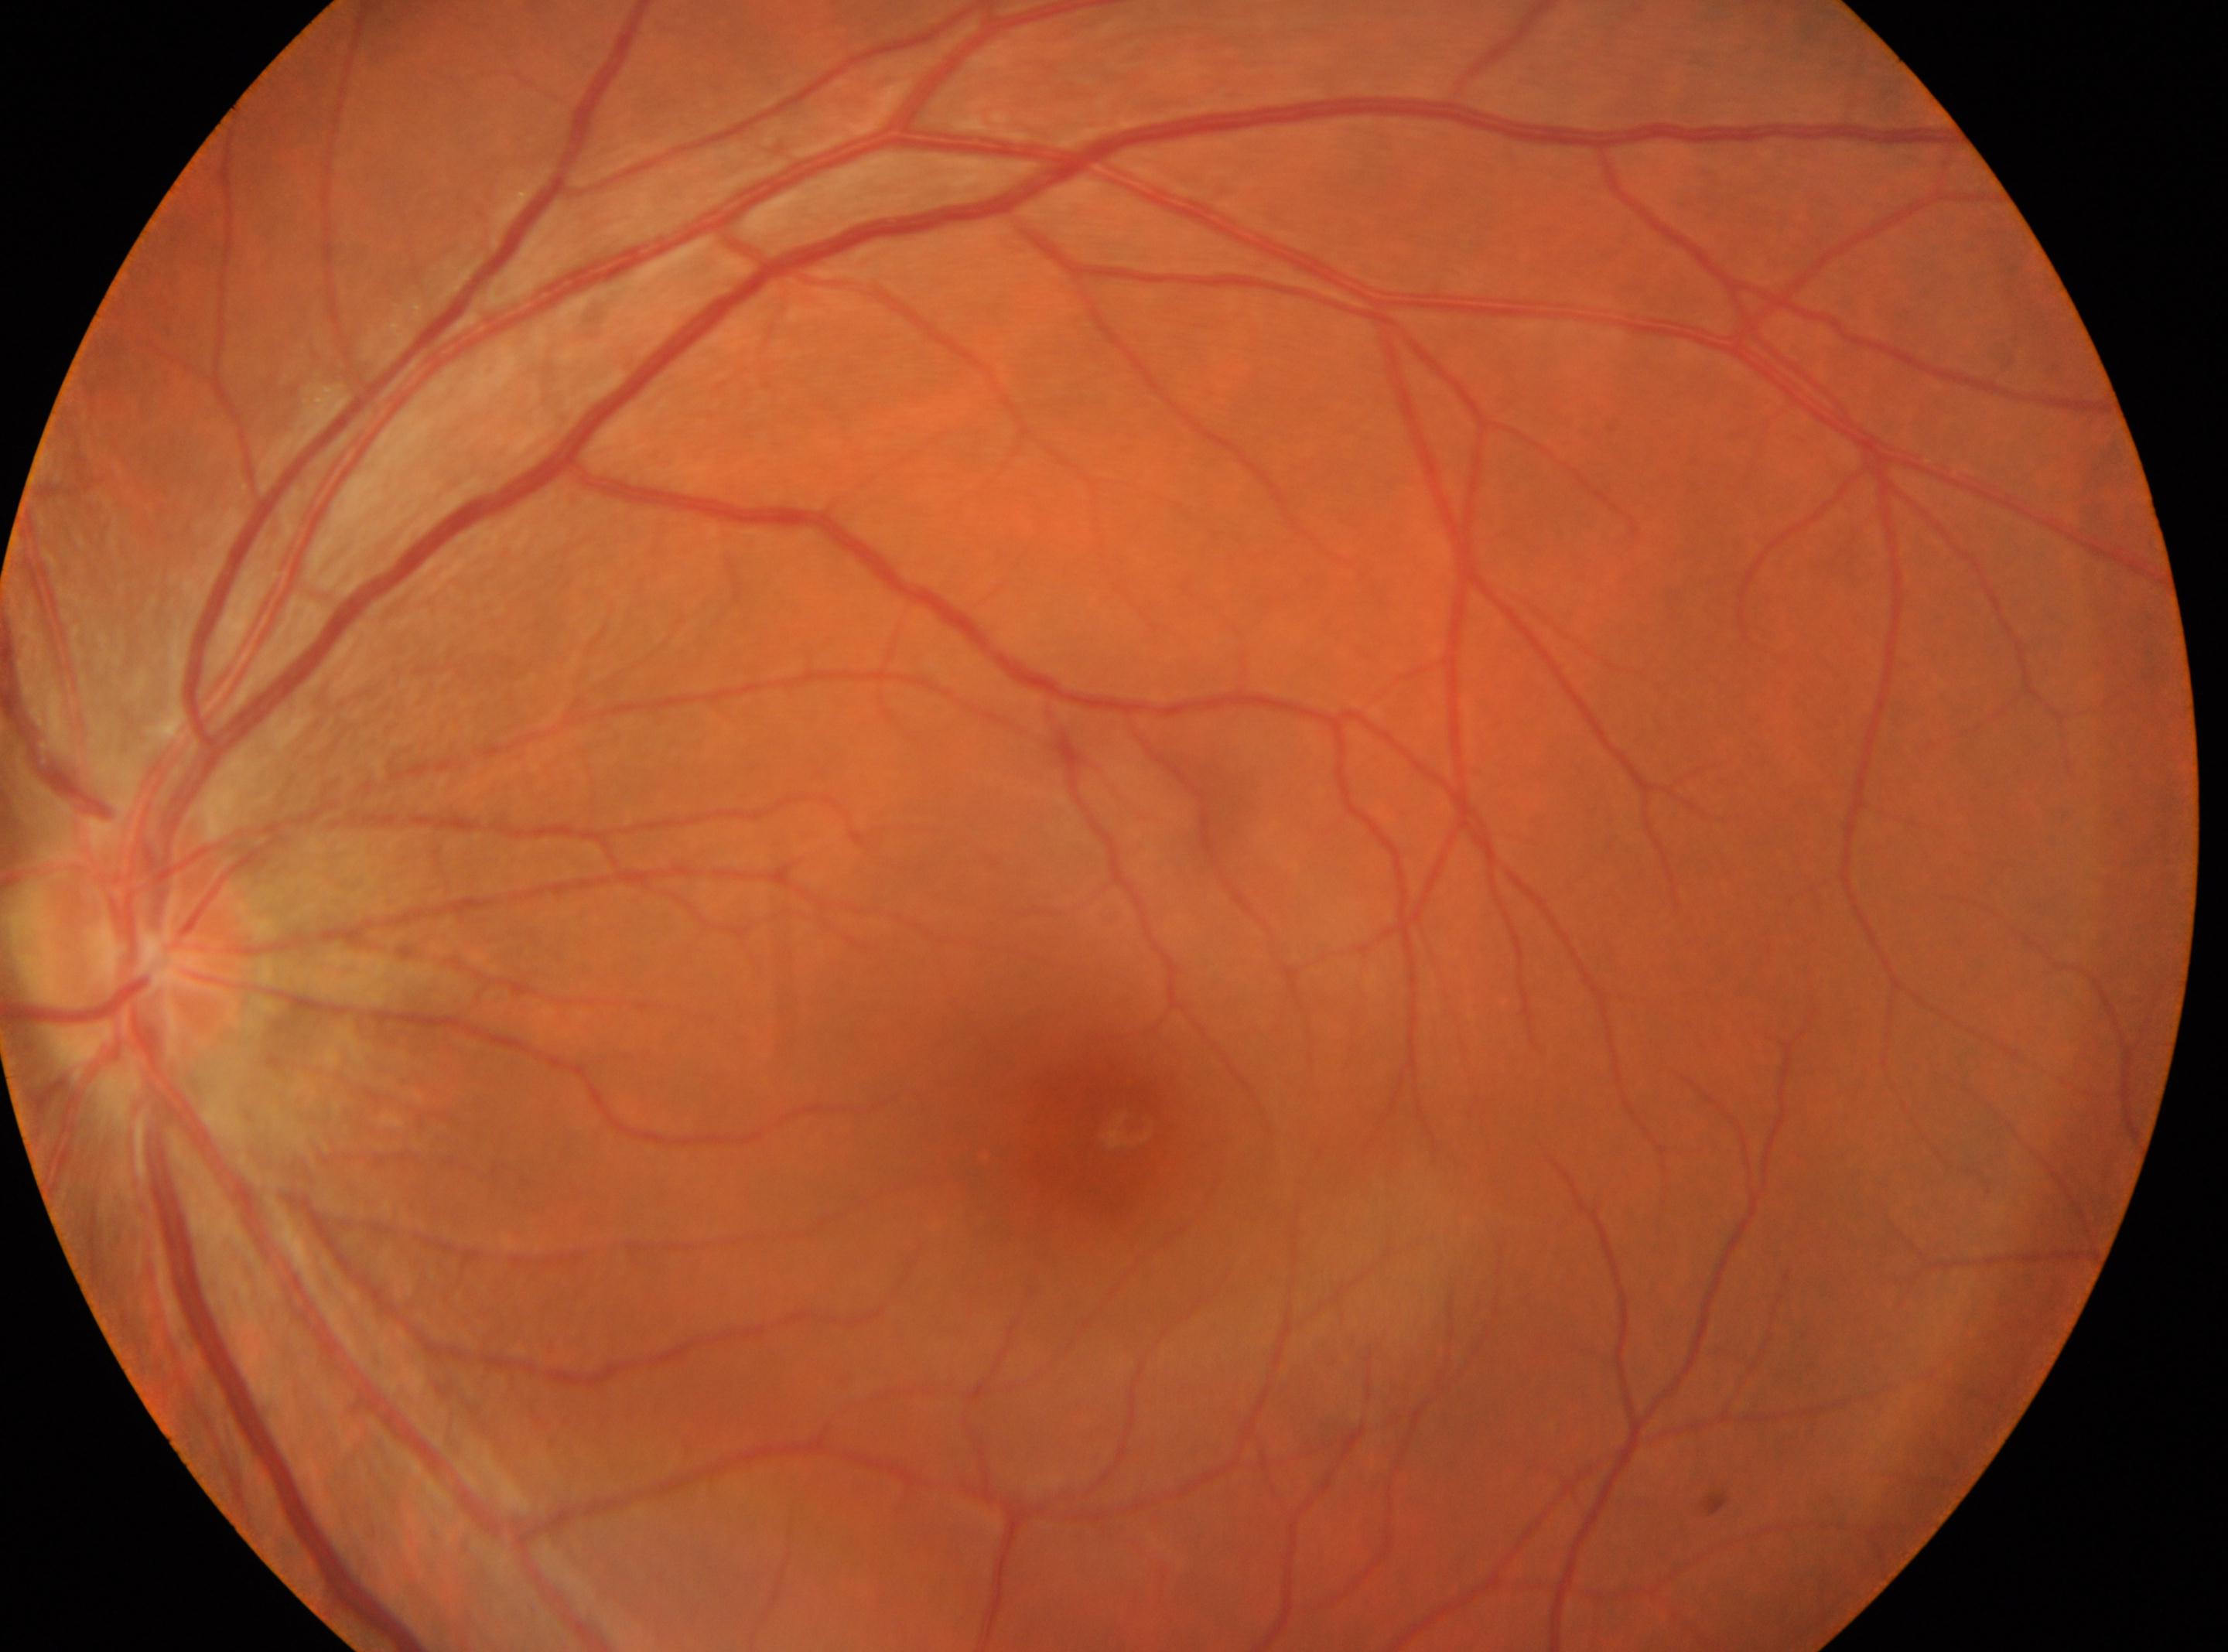
| feature | annotation |
|---|---|
| diabetic retinopathy (DR) | grade 0 (no apparent retinopathy) — no visible signs of diabetic retinopathy |
| laterality | left |
| DR impression | No apparent diabetic retinopathy |
| optic disc | 136, 952 |
| foveal center | 1128, 1126 |